Image size 640x480; Clarity RetCam 3, 130° FOV; wide-field fundus photograph from neonatal ROP screening: 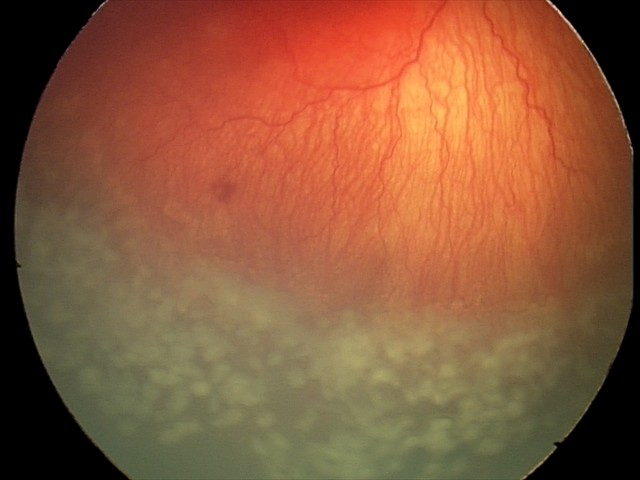

Impression: aggressive retinopathy of prematurity — rapidly progressive severe ROP with prominent plus disease, often without classic stage progression.